848 x 848 pixels — 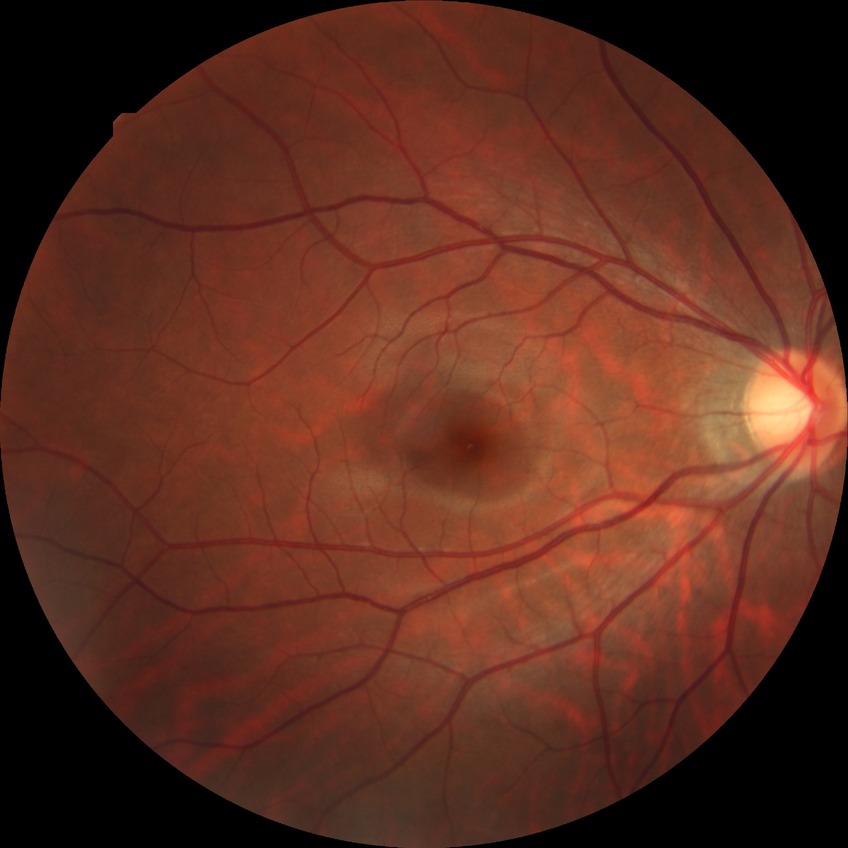
Diabetic retinopathy (DR): no diabetic retinopathy (NDR).